1240 by 1240 pixels · wide-field contact fundus photograph of an infant · 100° field of view (Phoenix ICON): 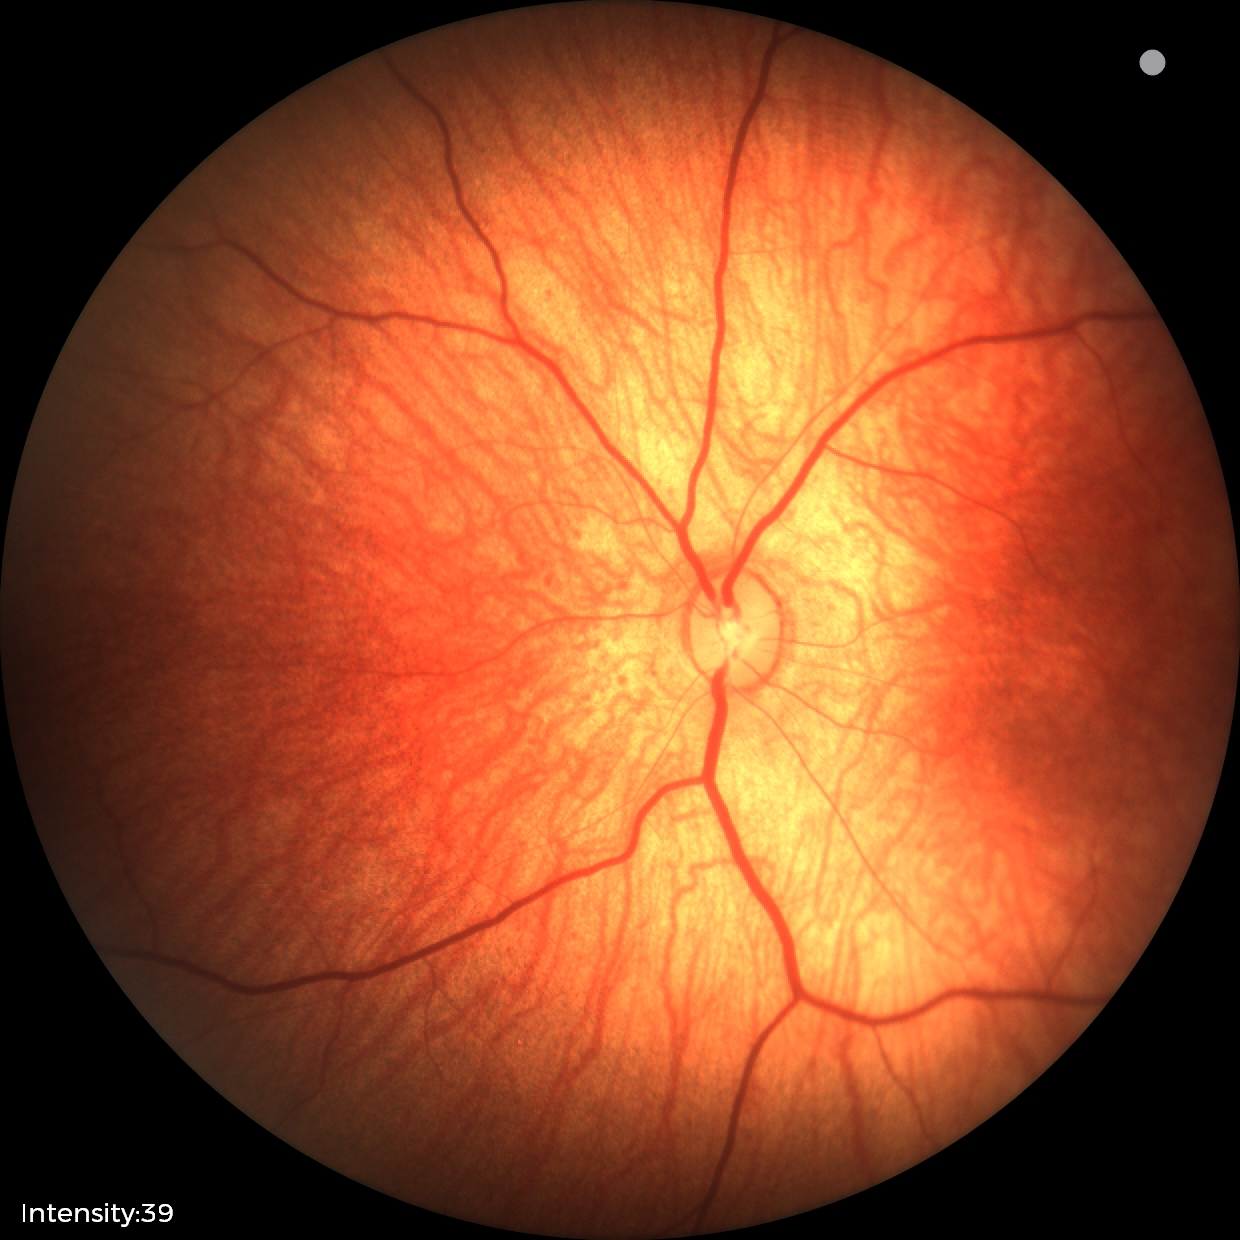 Screening examination with no abnormal retinal findings.